Pediatric retinal photograph (wide-field): 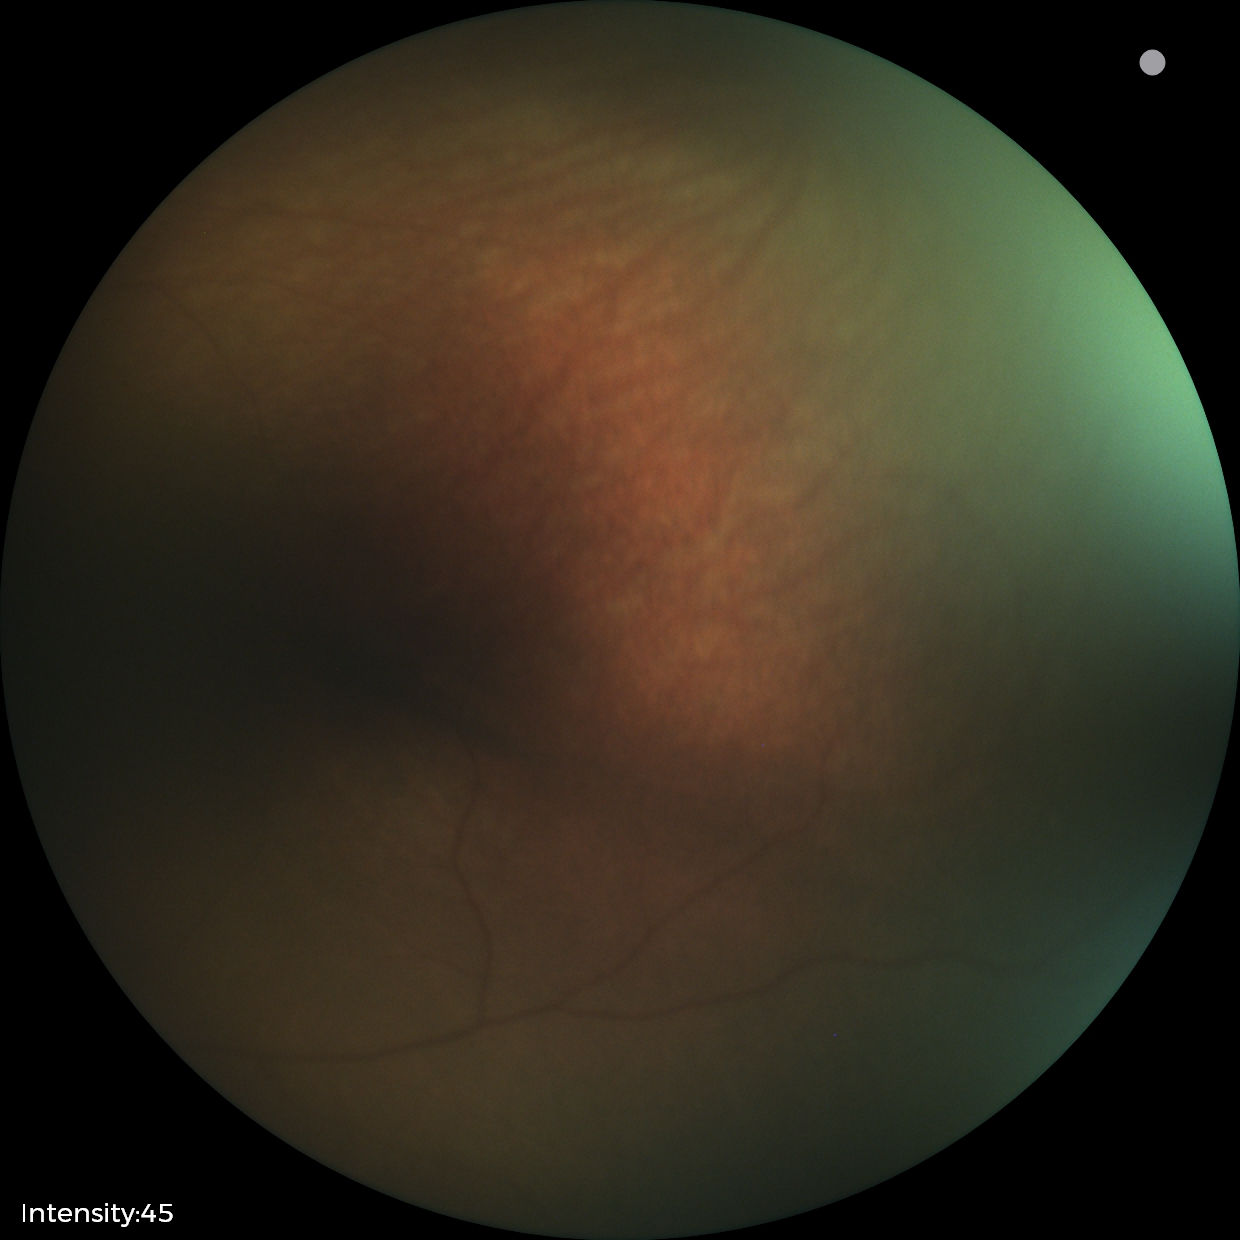 No retinal pathology identified on screening.